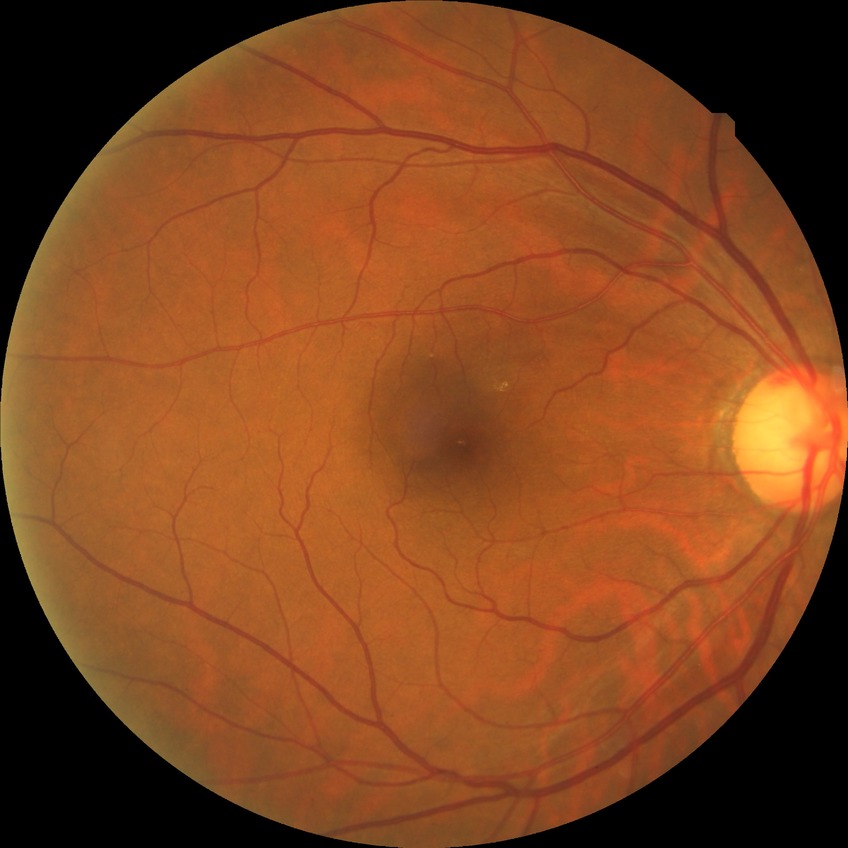

Retinopathy stage: no diabetic retinopathy.